Wide-field fundus photograph from neonatal ROP screening; 640 by 480 pixels
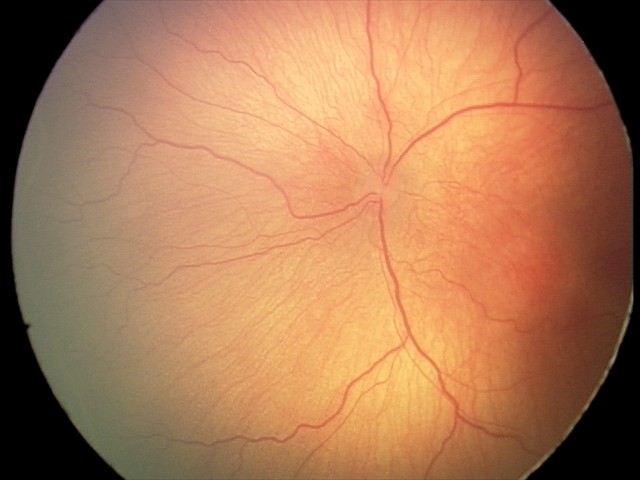 Q: What is the plus-form classification?
A: no plus disease
Q: What is the diagnosis from this examination?
A: ROP stage 1